848 by 848 pixels
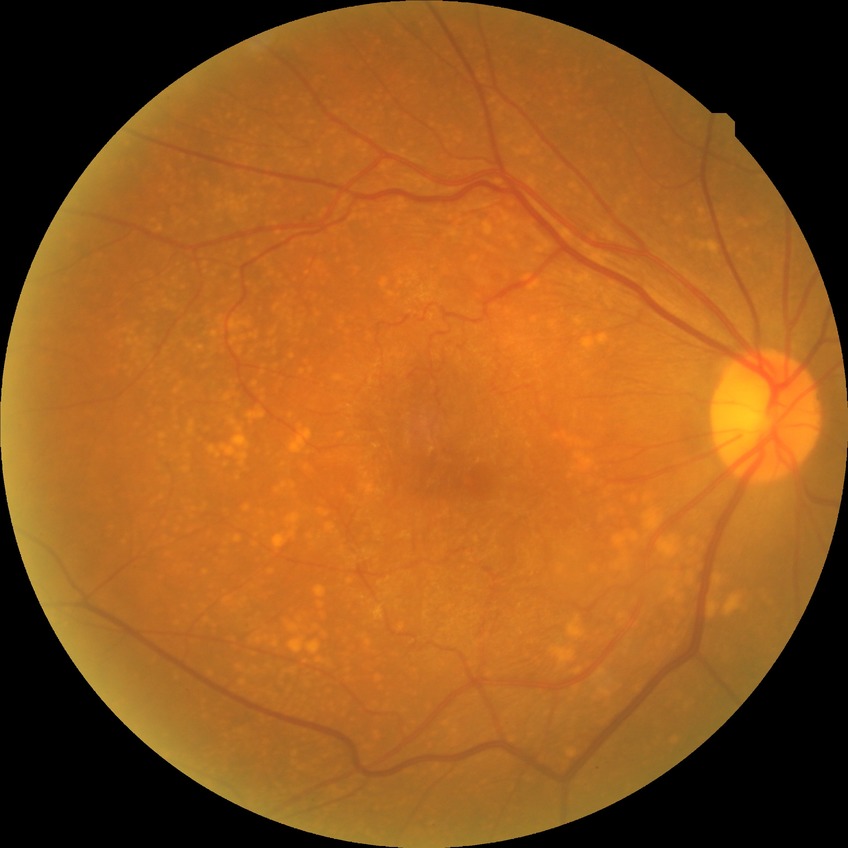
diabetic retinopathy (DR) = NDR (no diabetic retinopathy)